Wide-field fundus image from infant ROP screening; 100° field of view (Phoenix ICON):
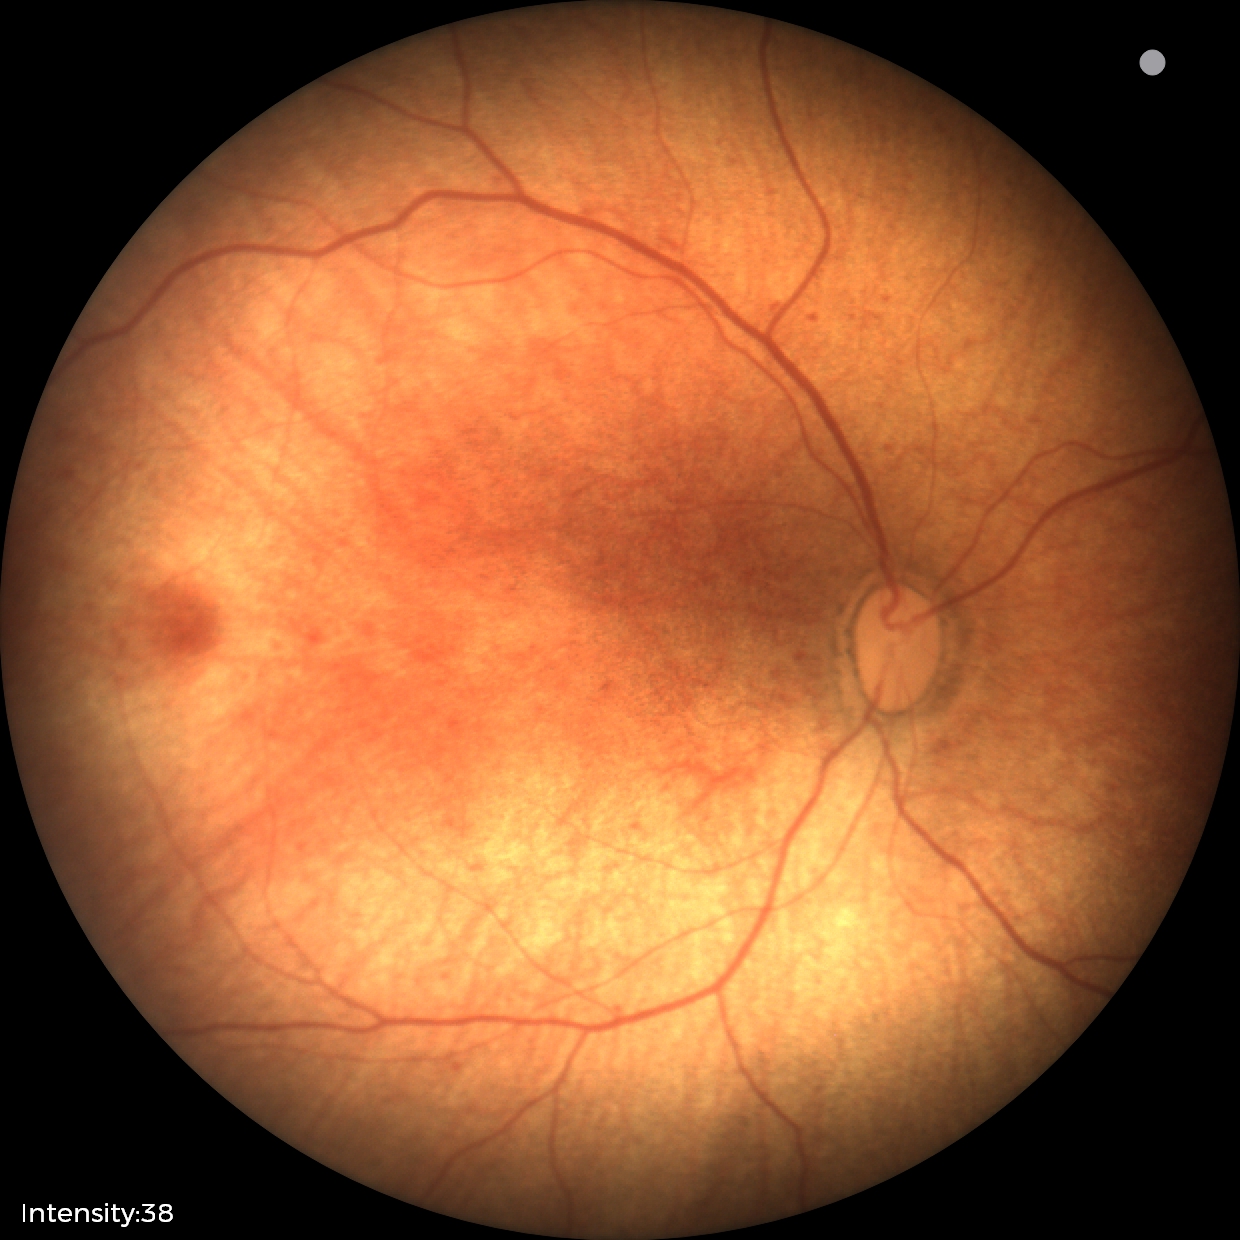

Physiological retinal appearance for postconceptual age.